130° field of view (Clarity RetCam 3). Pediatric wide-field fundus photograph
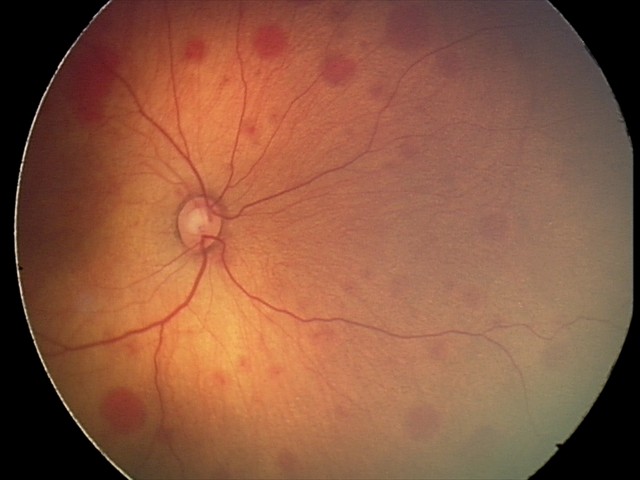
Series diagnosed as retinal hemorrhages.